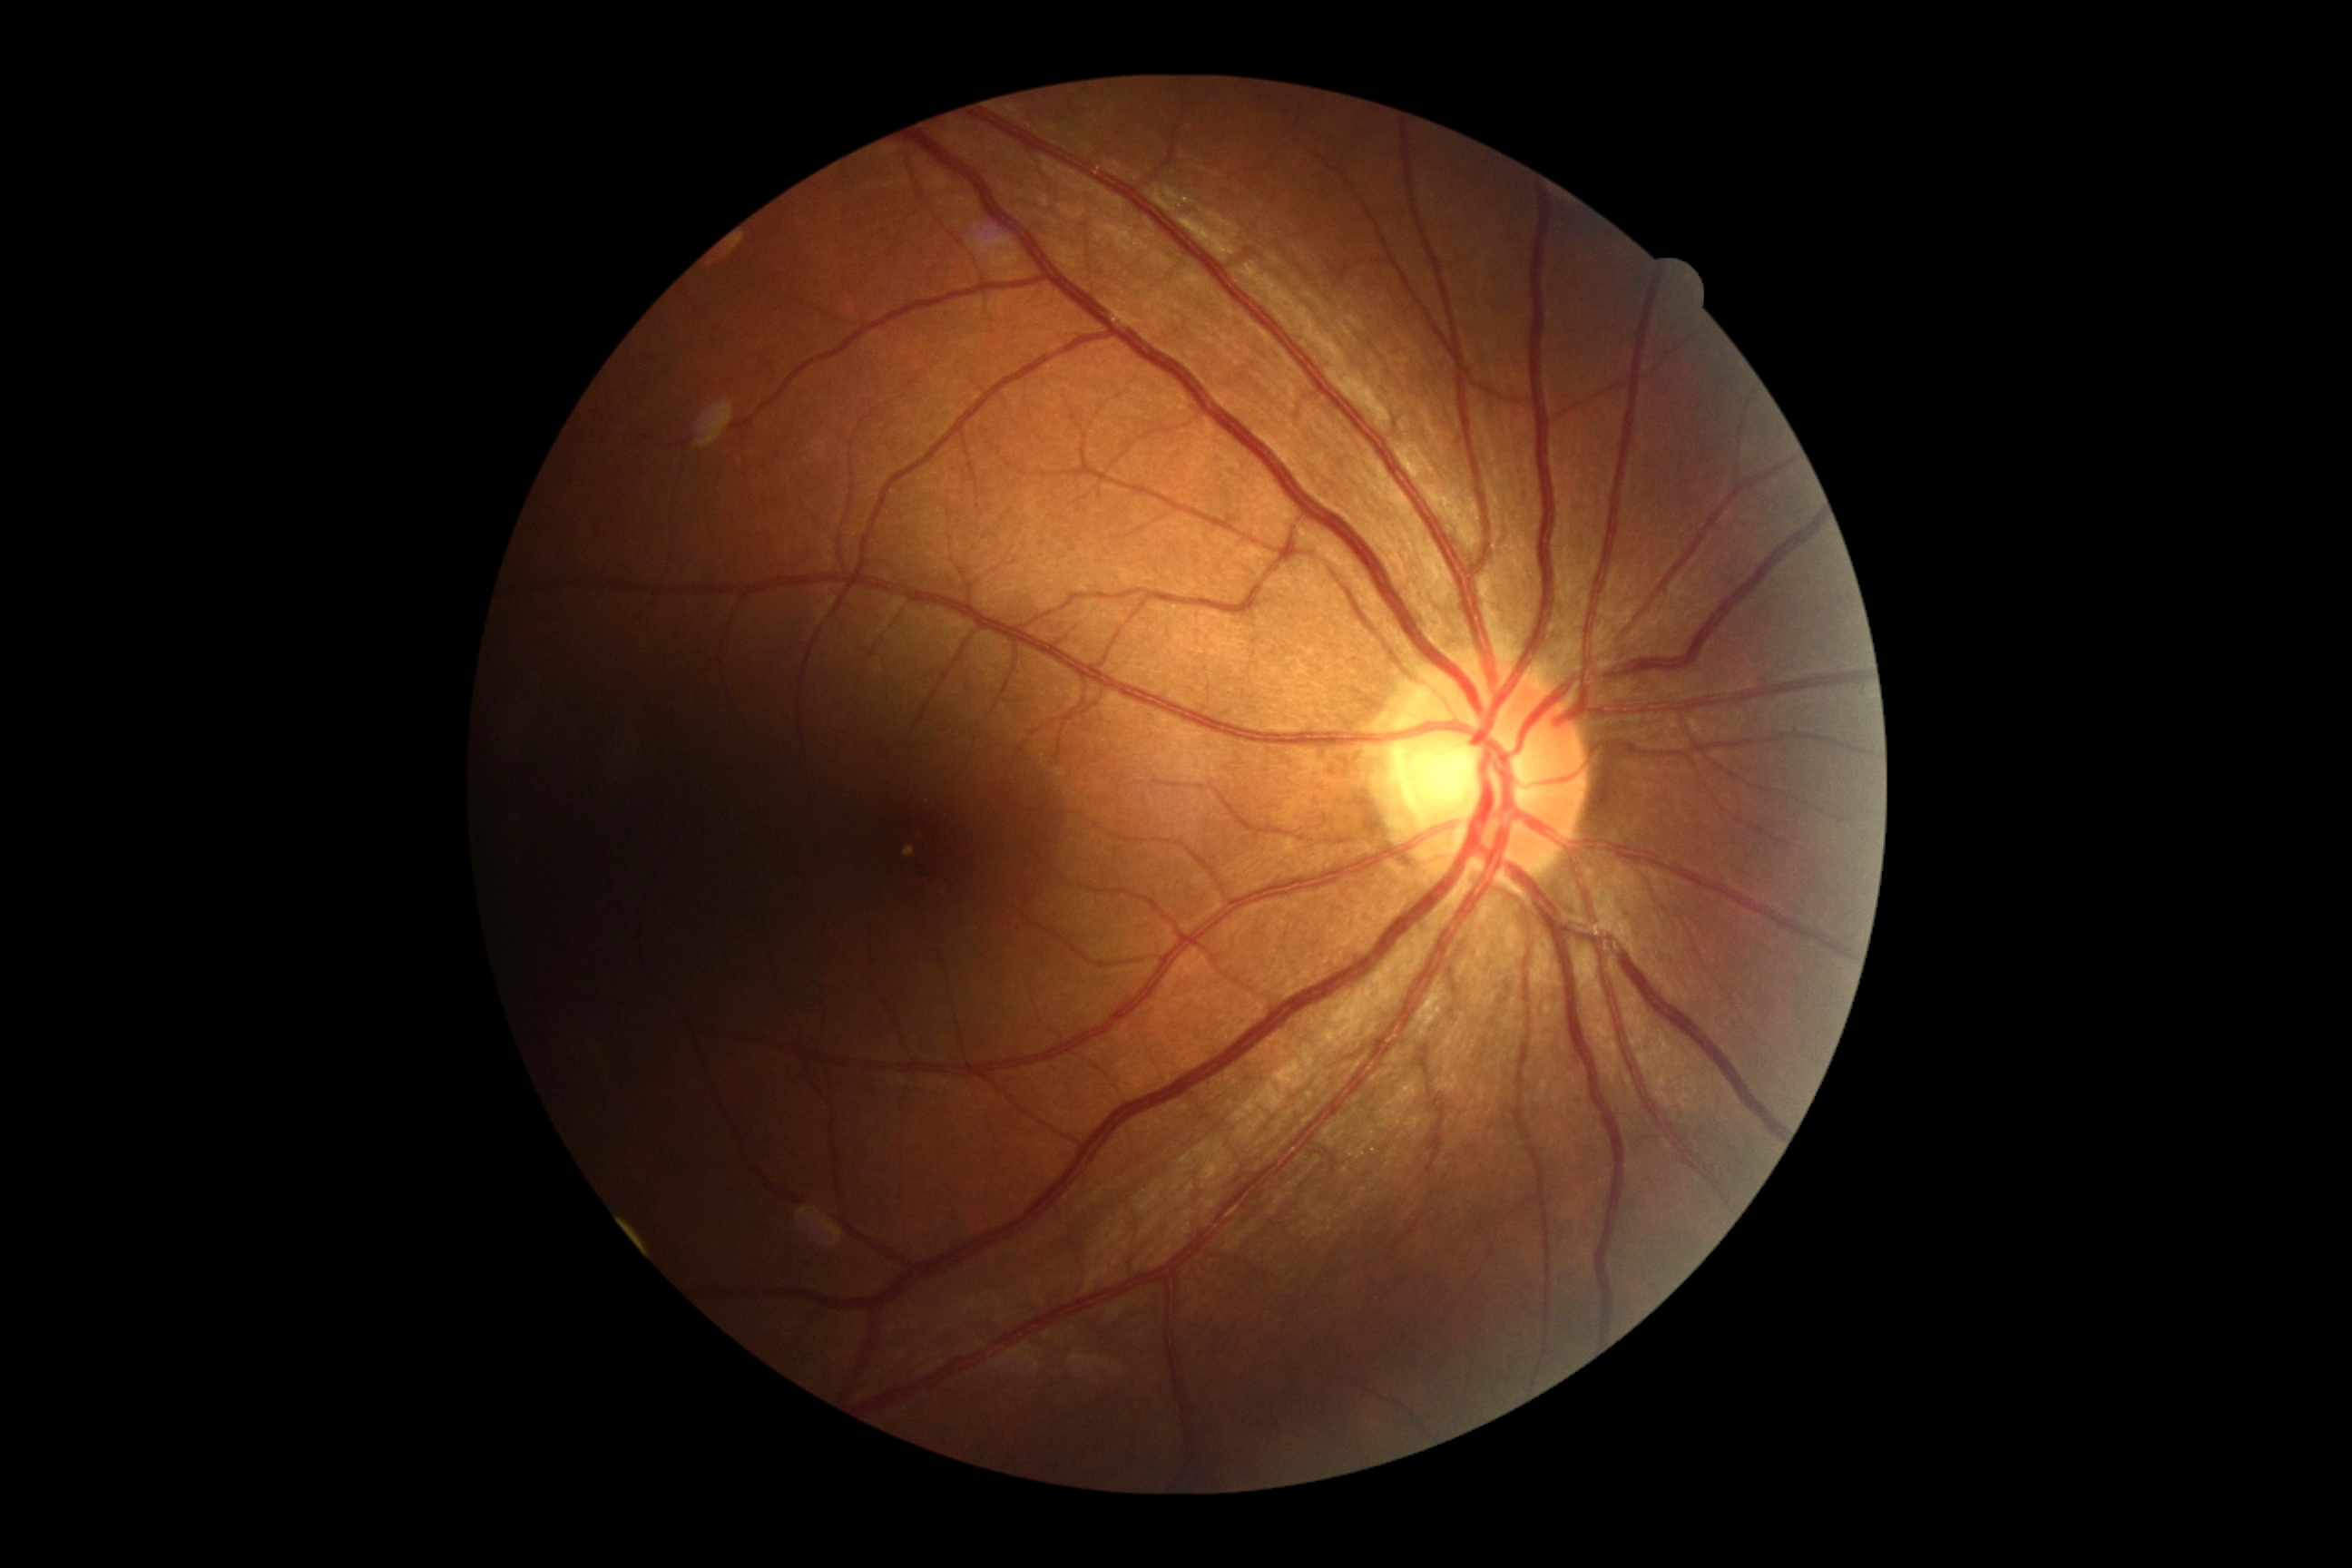 Findings:
* DR impression: negative for DR
* DR: grade 0